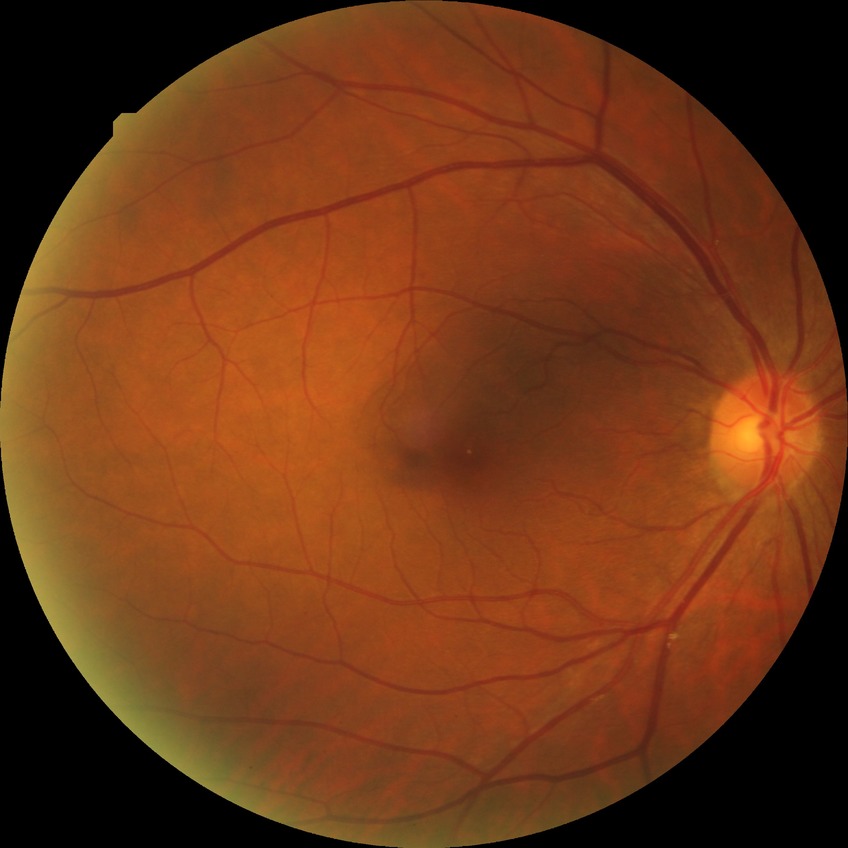

DR is SDR.